45° field of view. Fundus photo
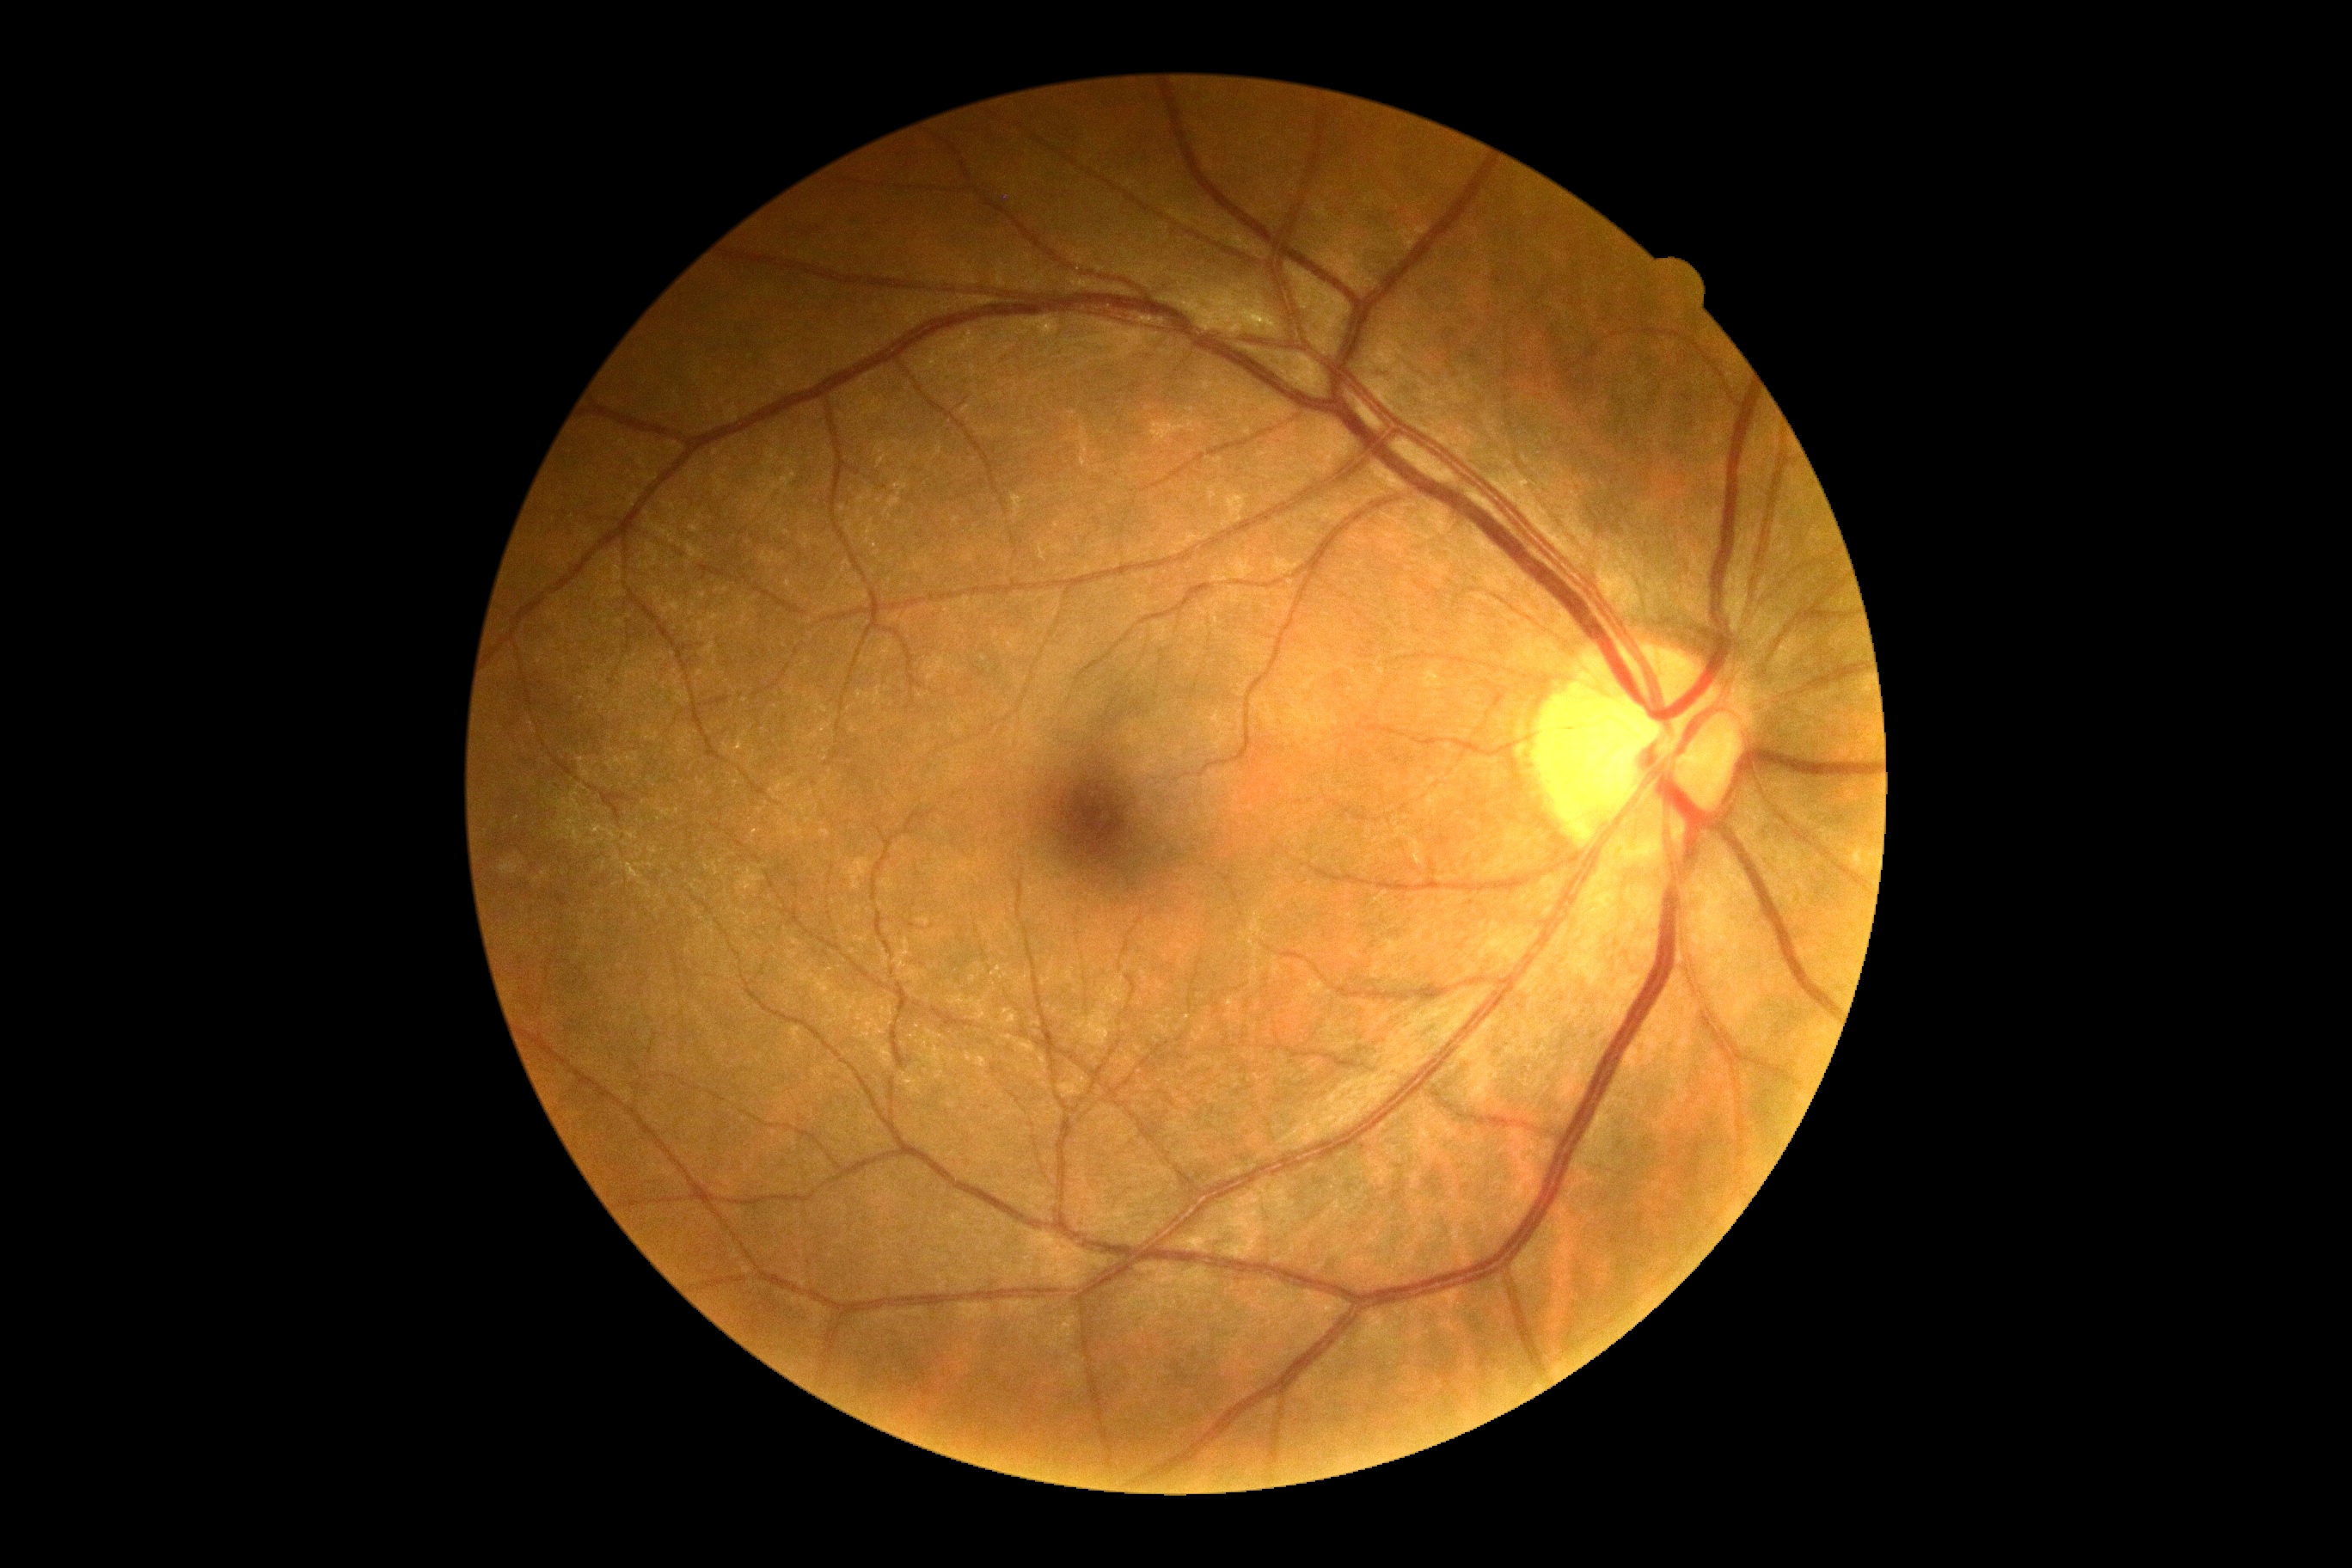
No DR findings. Retinopathy grade is 0.